2184 x 1690 pixels.
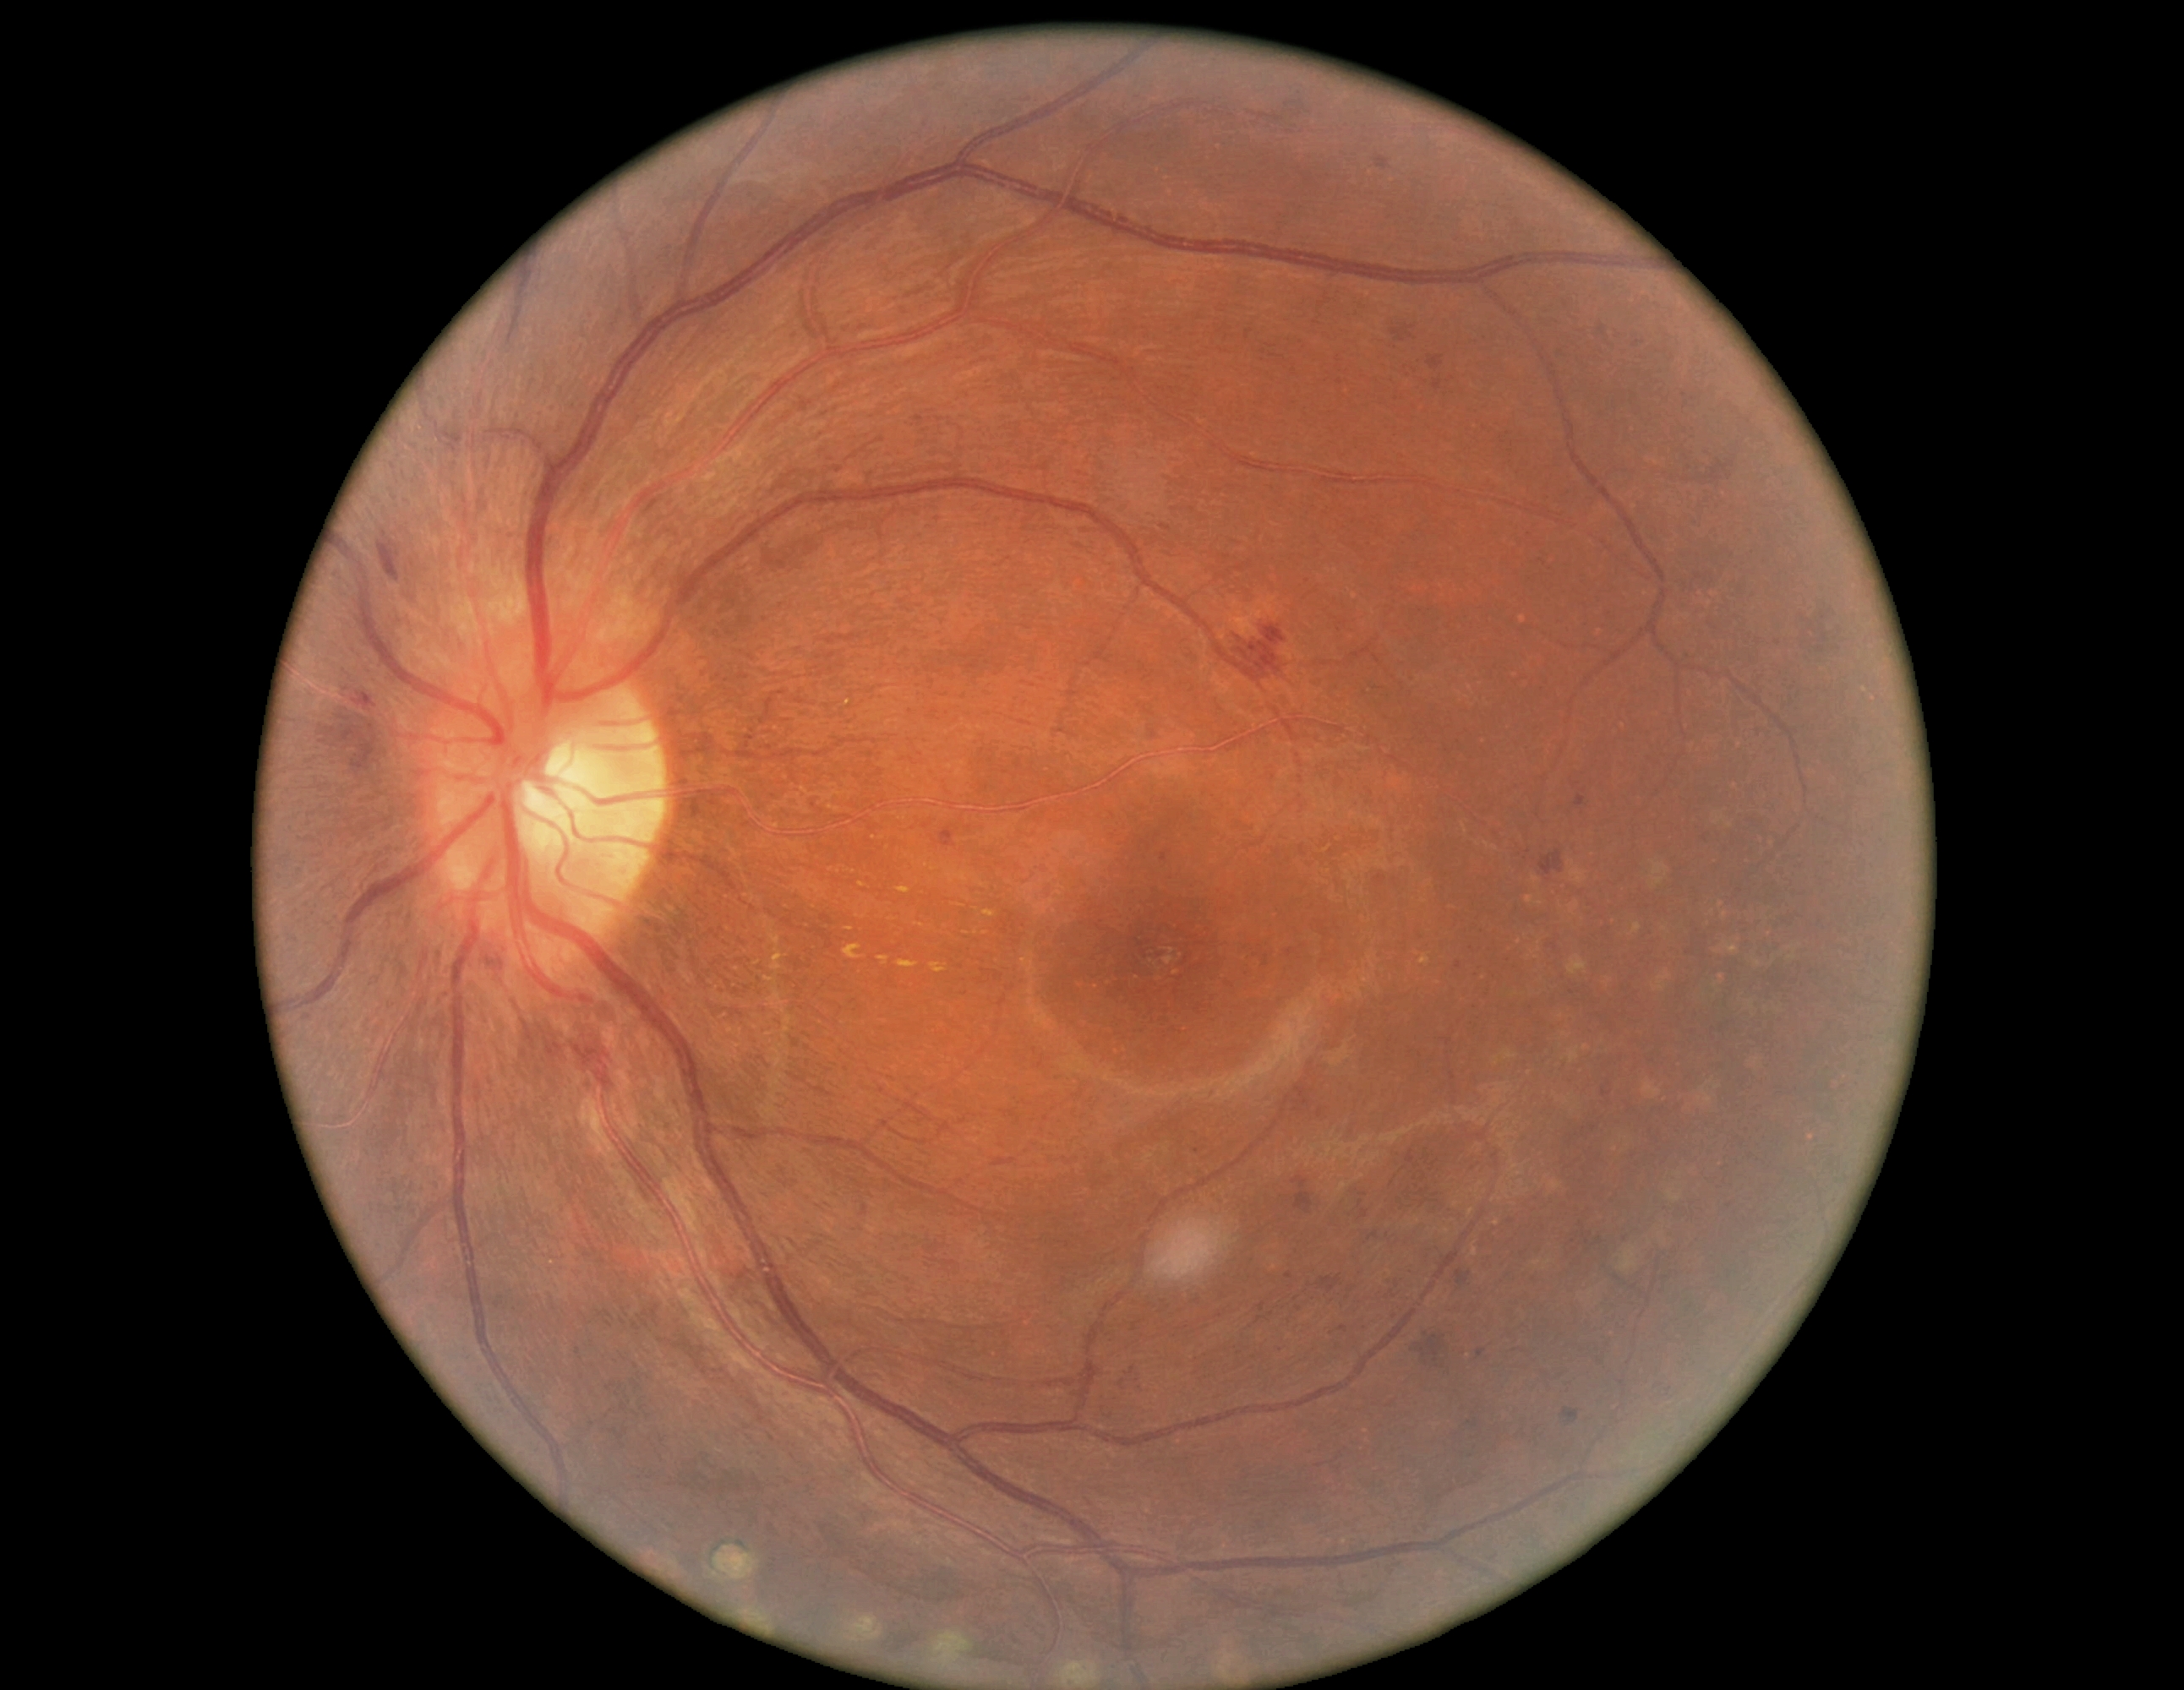 DR: moderate NPDR (grade 2).